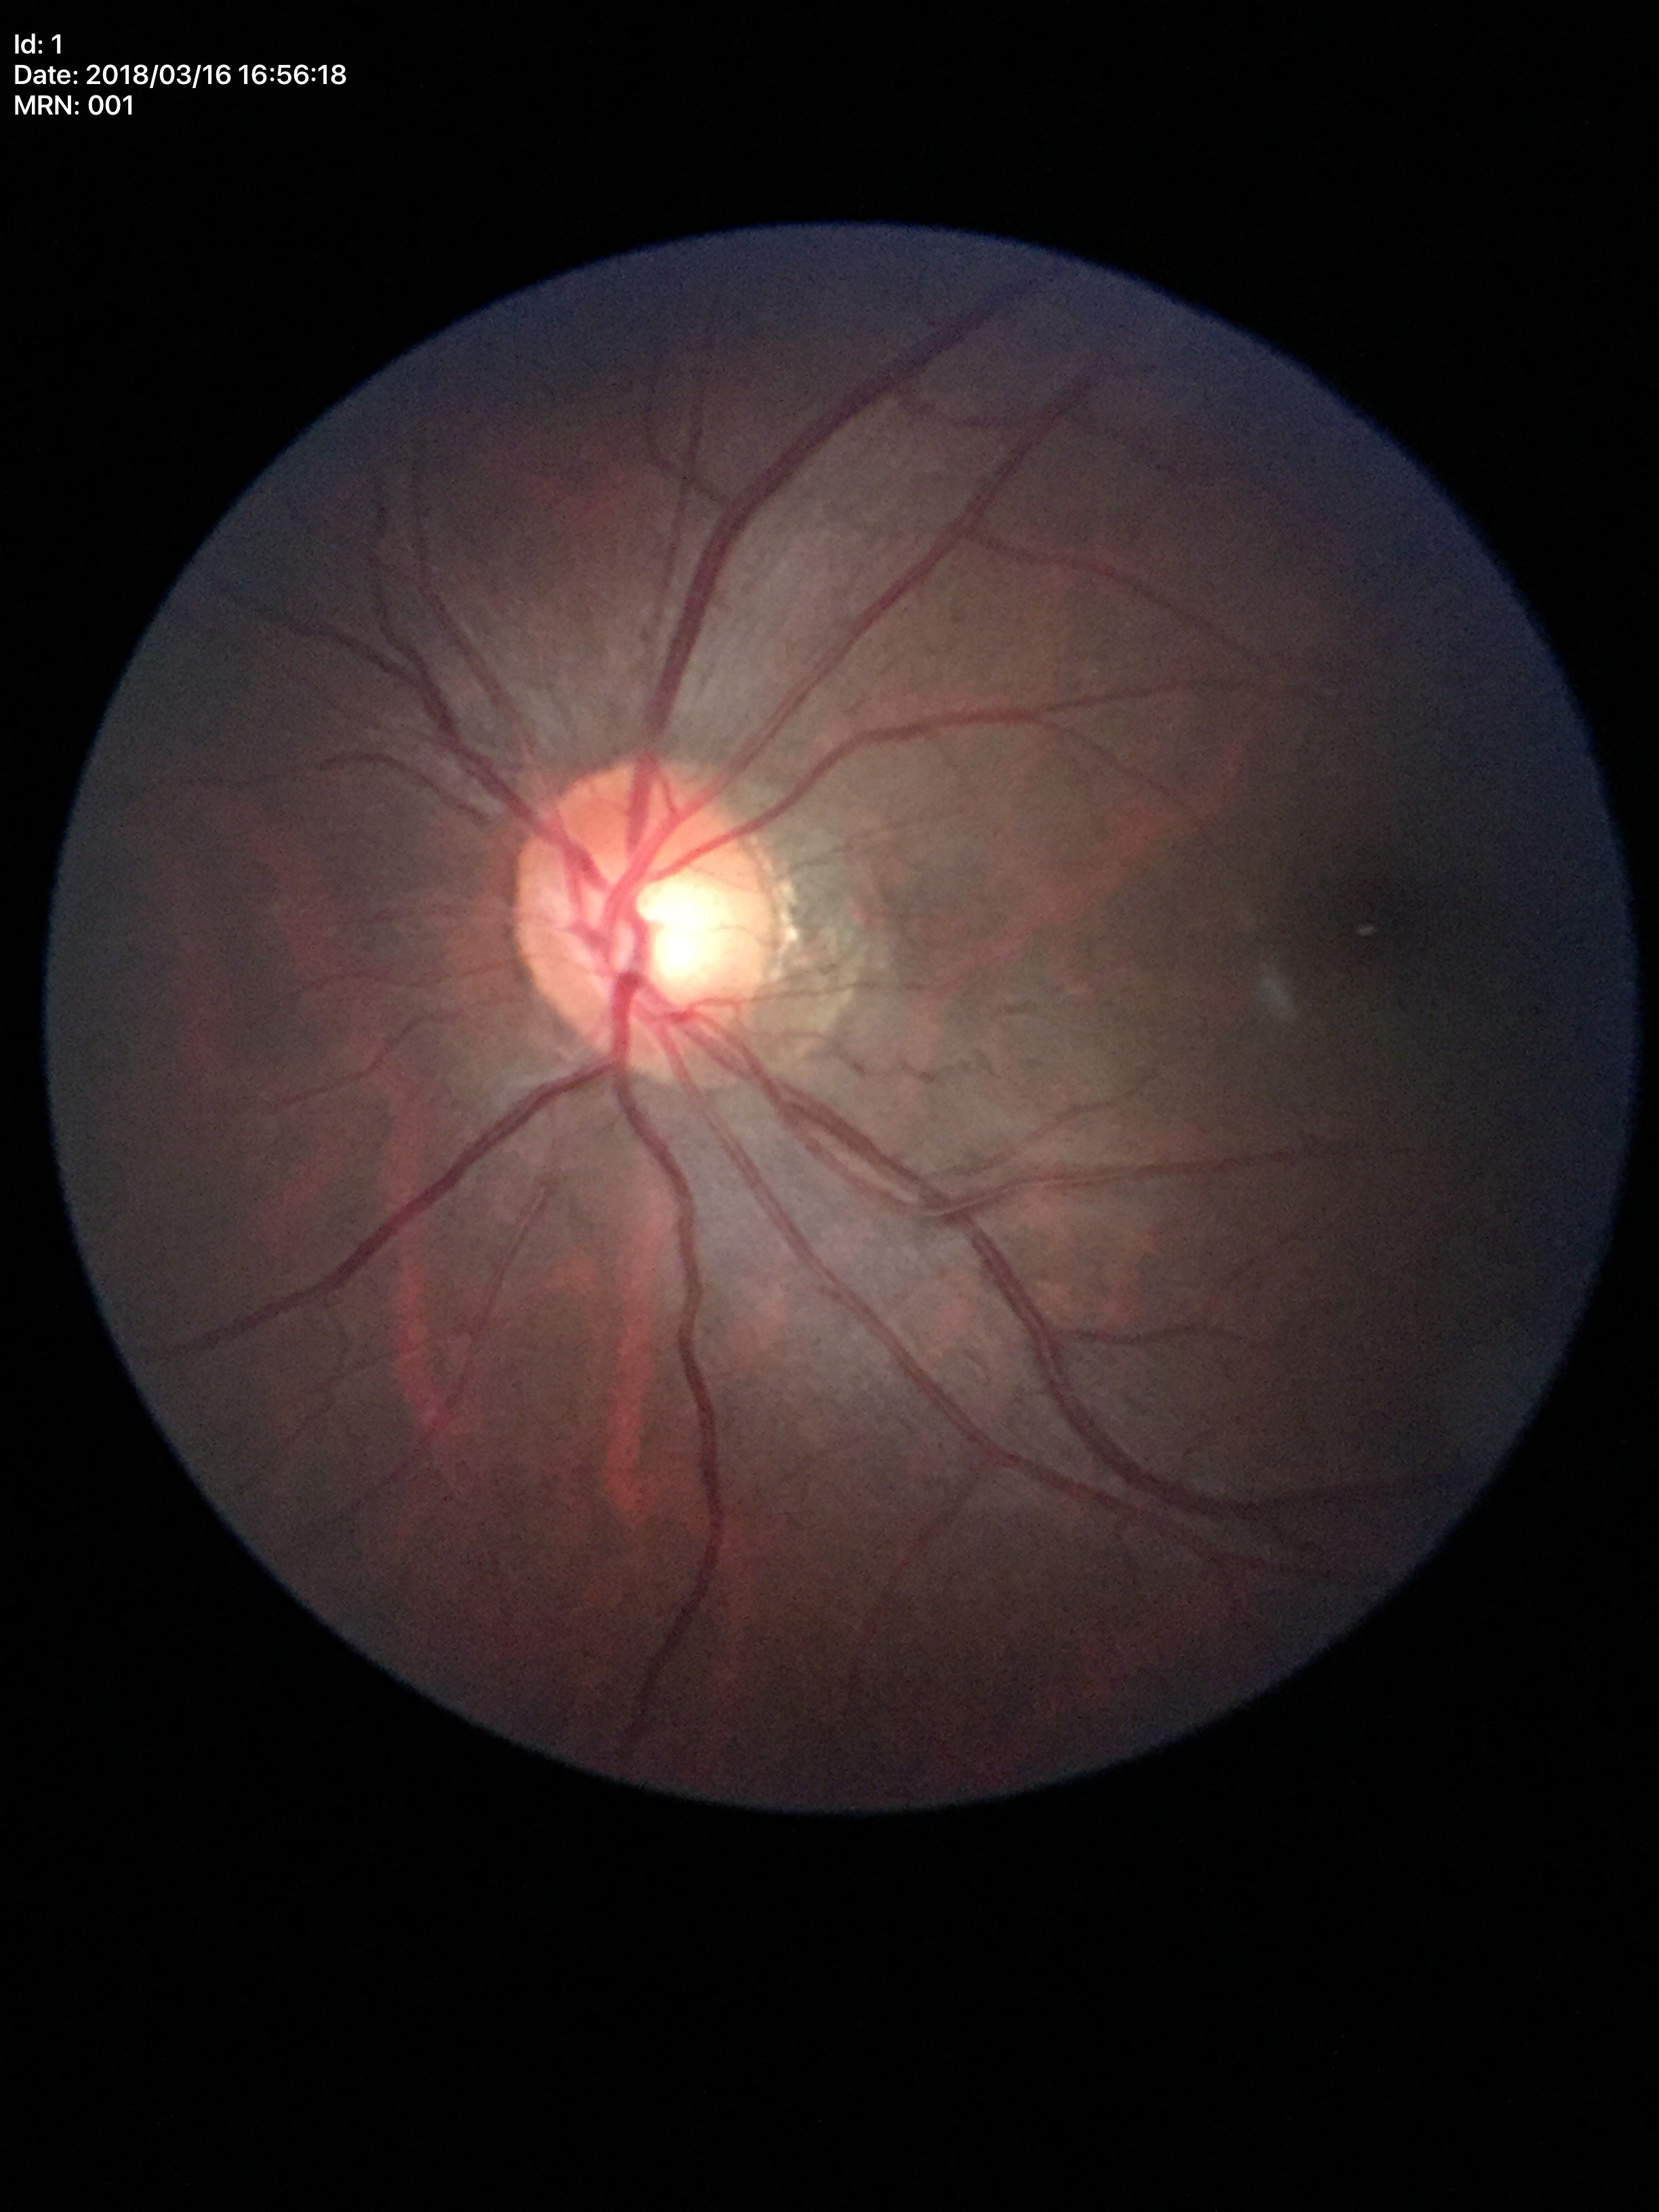
Glaucoma evaluation: no suspicious findings.
Horizontal cup-to-disc ratio of 0.59.
Vertical C/D ratio is 0.52.